DR severity per modified Davis staging — 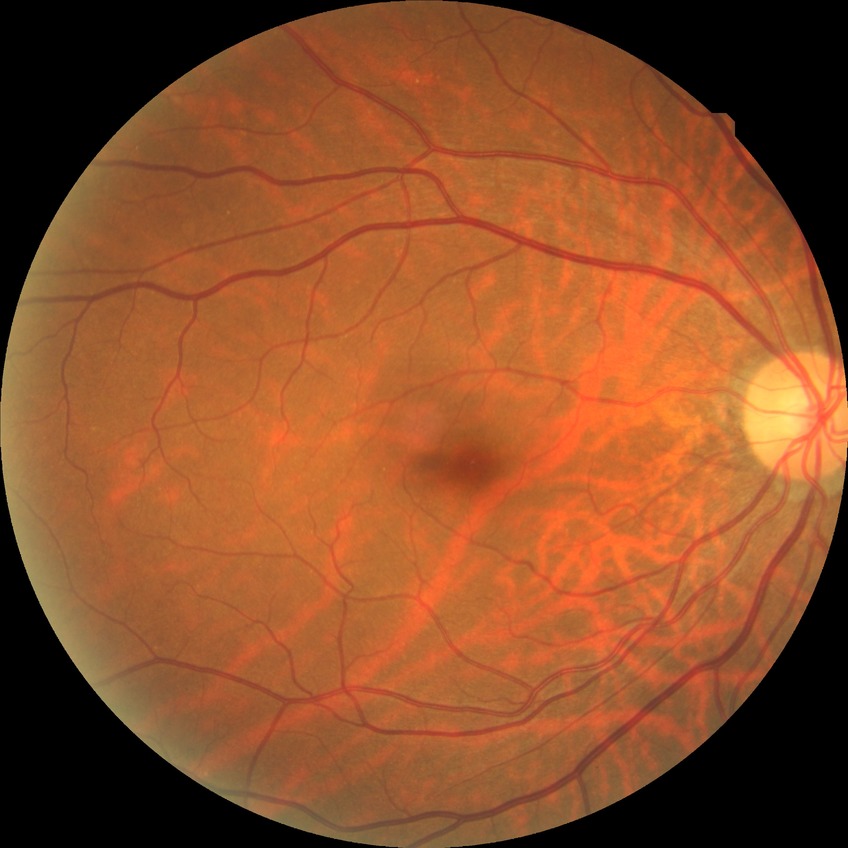
Modified Davis classification is no diabetic retinopathy.